640 by 480 pixels · RetCam wide-field infant fundus image:
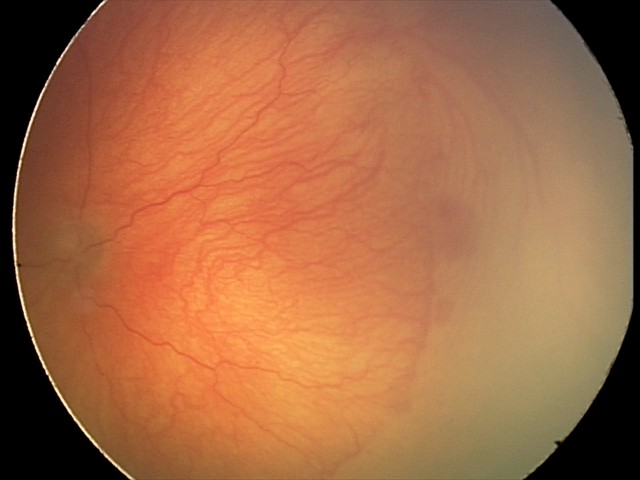

From an examination with diagnosis of aggressive retinopathy of prematurity (A-ROP).